Image size 1659x2212 · acquired with a Remidio FOP fundus camera.
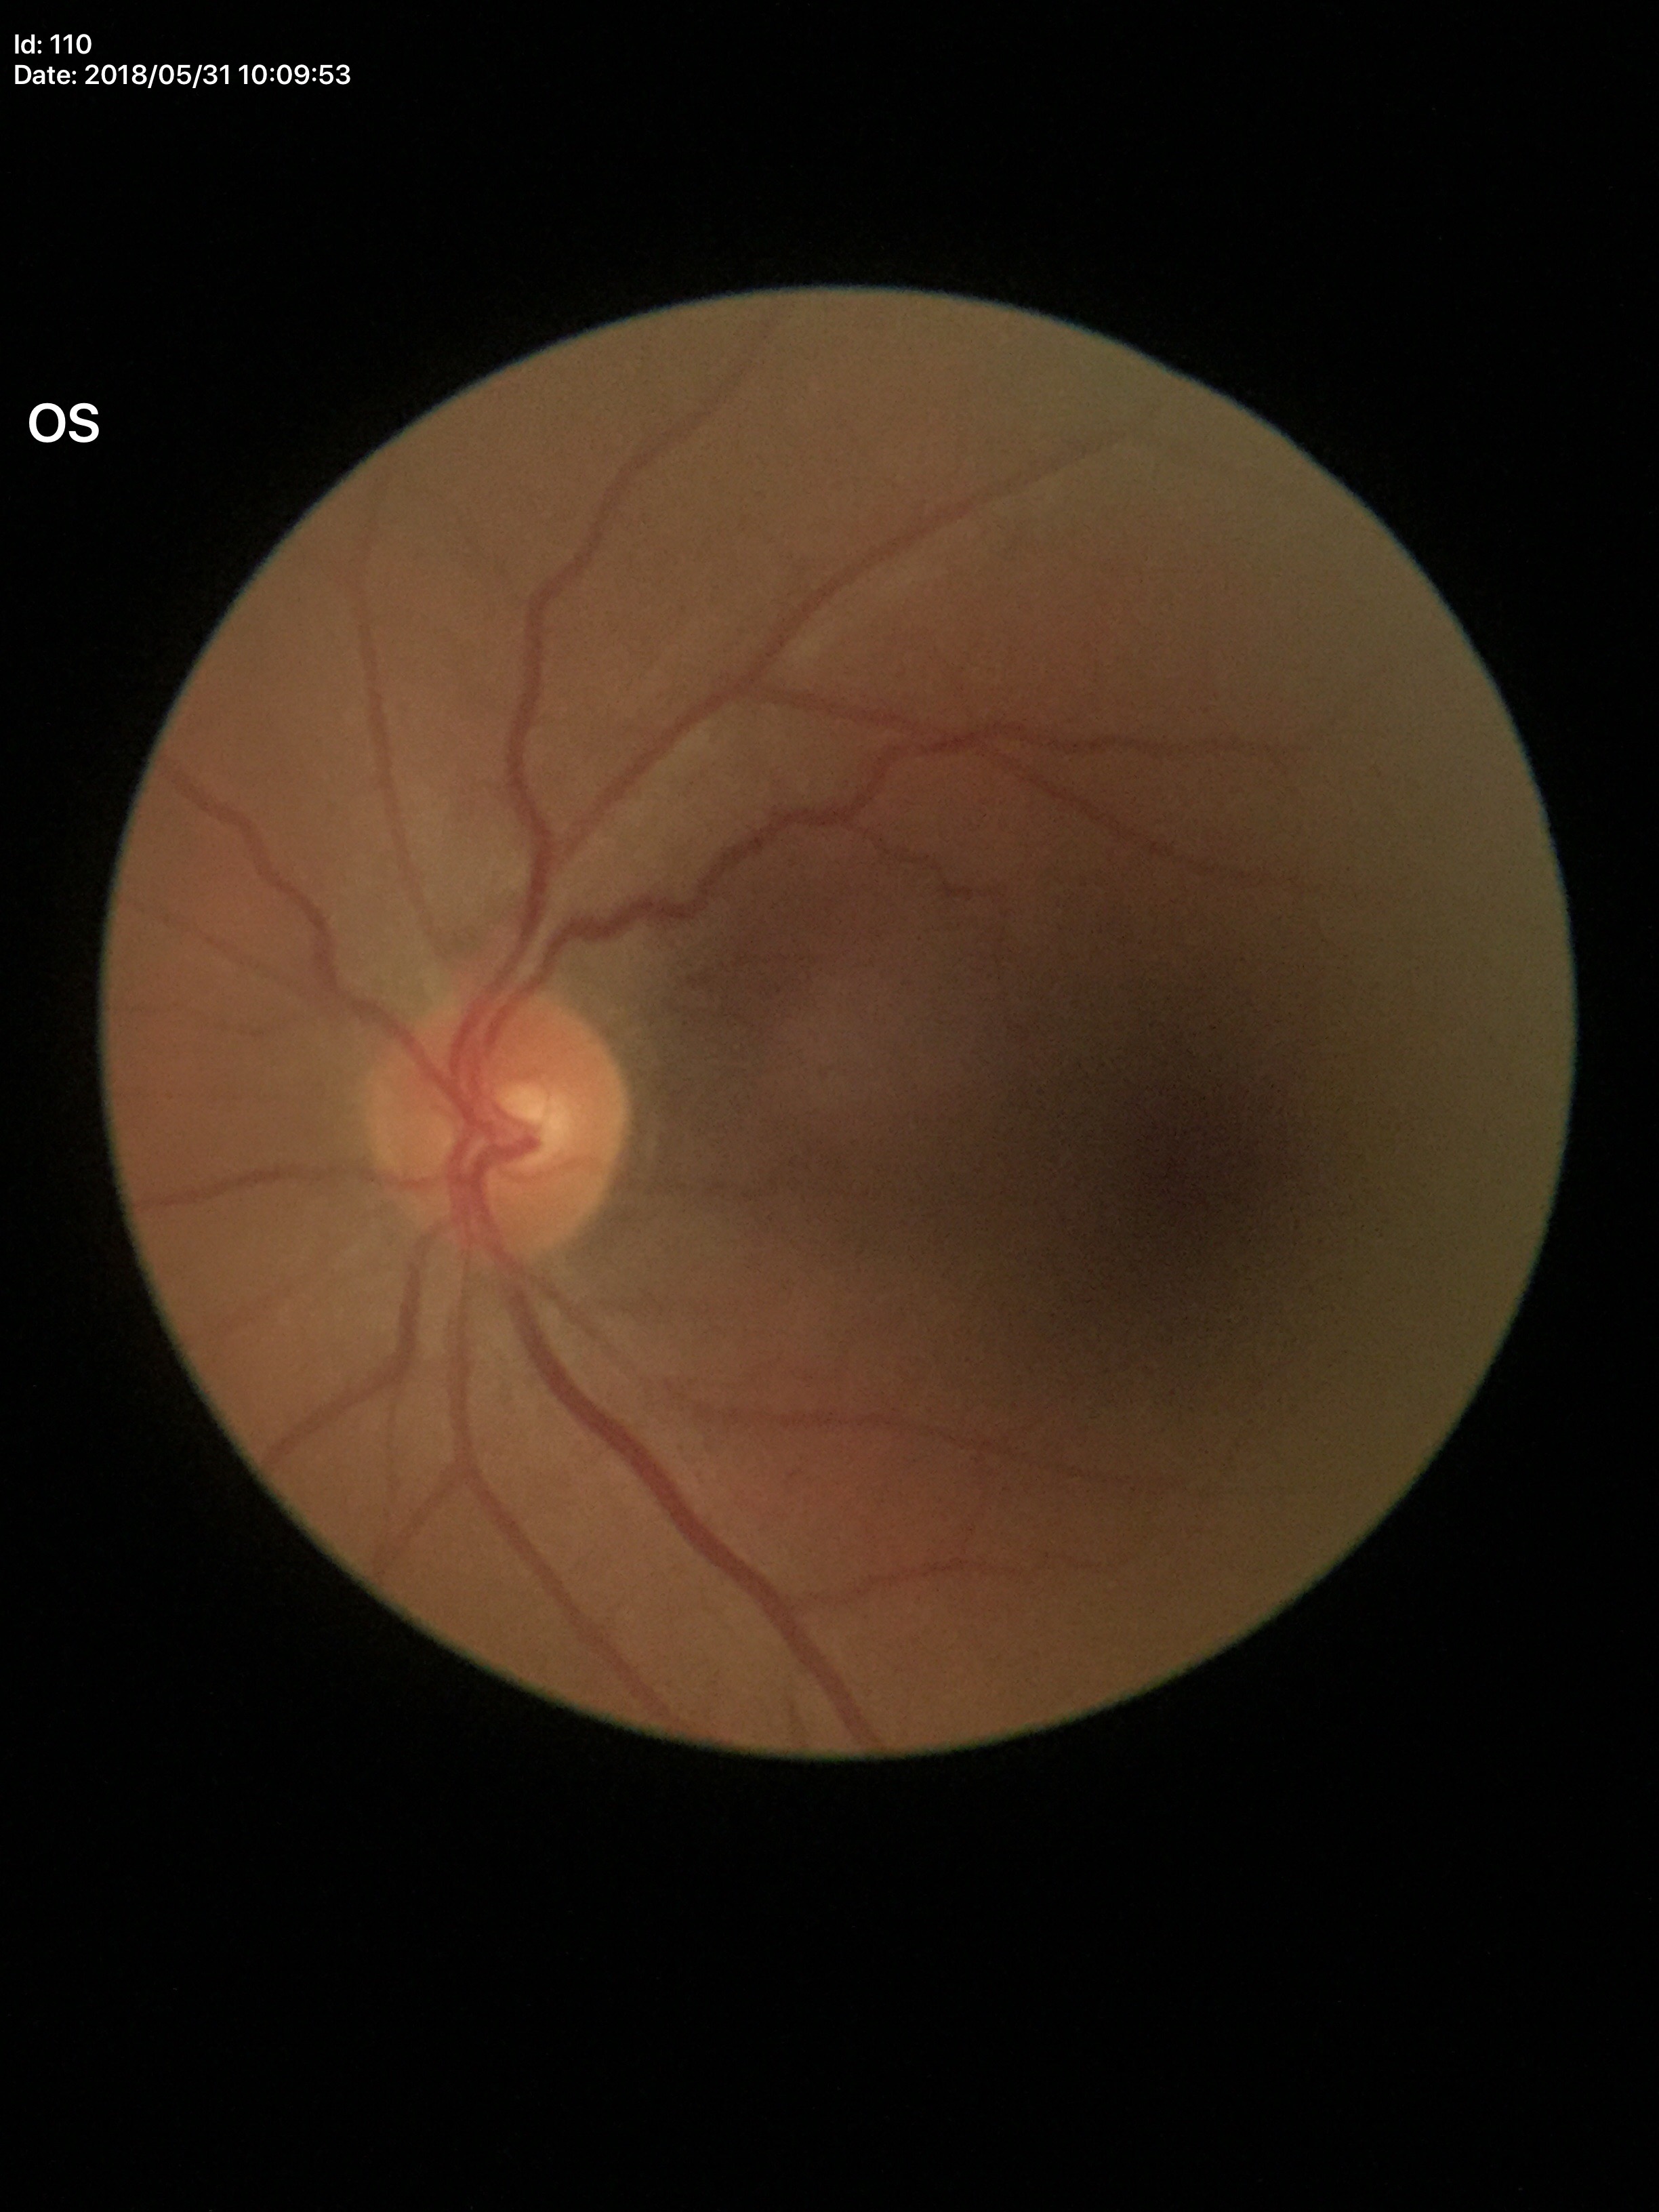
Glaucoma screening impression: negative (5/5 ophthalmologists in agreement); vertical CDR: 0.40